CFP — 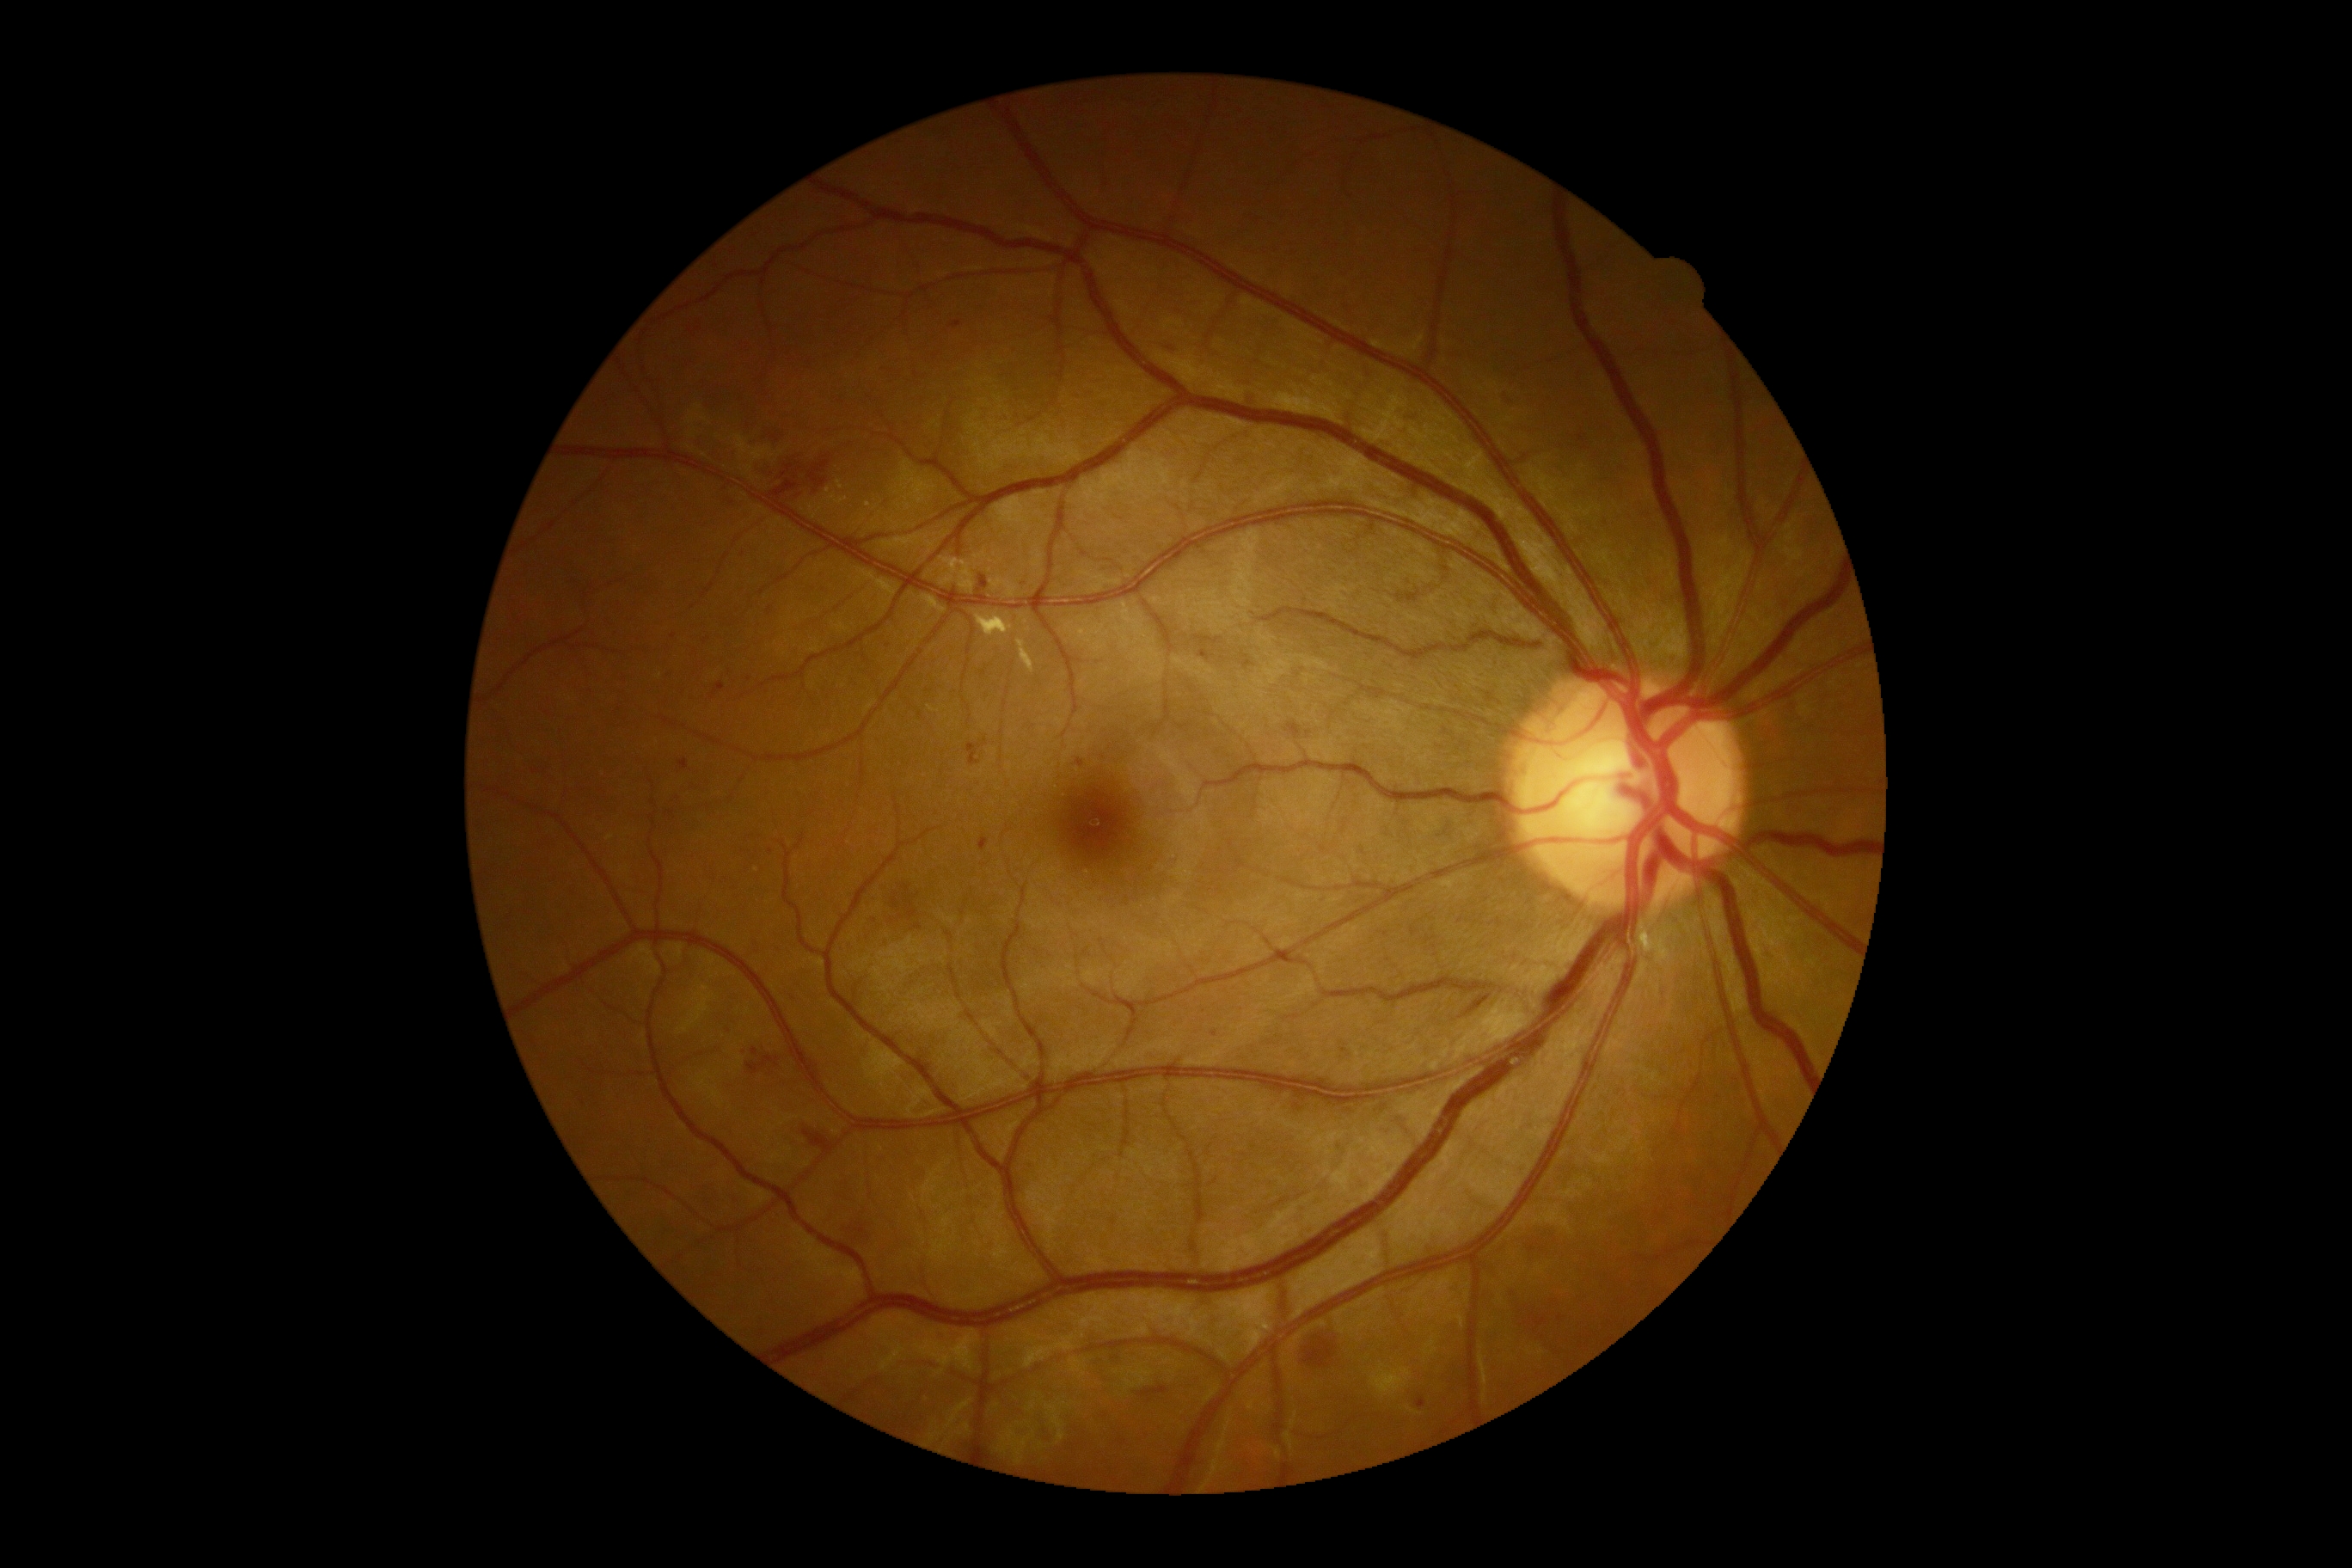 DR stage: grade 2 (moderate NPDR) — more than just microaneurysms but less than severe NPDR; non-proliferative diabetic retinopathy
Lesions identified (partial list):
• HEs (partial): <box>769,481,799,505</box>; <box>804,1129,835,1151</box>; <box>752,1048,759,1057</box>; <box>893,898,900,910</box>; <box>809,456,831,487</box>; <box>905,895,919,921</box>; <box>1304,1337,1337,1369</box>; <box>754,496,769,505</box>; <box>1502,396,1510,408</box>; <box>761,463,793,484</box>; <box>747,1057,780,1075</box>; <box>1467,995,1491,1015</box>
• Smaller HEs around x=919 y=926; x=1532 y=1250; x=906 y=889
• SEs: none identified
• EXs: <box>1017,639,1034,675</box>; <box>1648,931,1660,945</box>; <box>976,613,1014,637</box>
• MAs: <box>1077,759,1084,768</box>; <box>678,759,689,771</box>; <box>711,683,725,701</box>; <box>1418,1399,1426,1409</box>; <box>977,575,988,596</box>; <box>967,738,988,766</box>; <box>952,321,962,328</box>; <box>1533,1313,1548,1330</box>; <box>1199,651,1213,661</box>; <box>855,1227,866,1234</box>; <box>1244,661,1253,670</box>; <box>981,836,989,852</box>; <box>1285,723,1302,738</box>; <box>768,606,773,616</box>
• Smaller MAs around x=1298 y=1108; x=749 y=679; x=1340 y=1147; x=1214 y=1035; x=1344 y=1050; x=771 y=852